2089 by 1764 pixels · retinal fundus photograph: 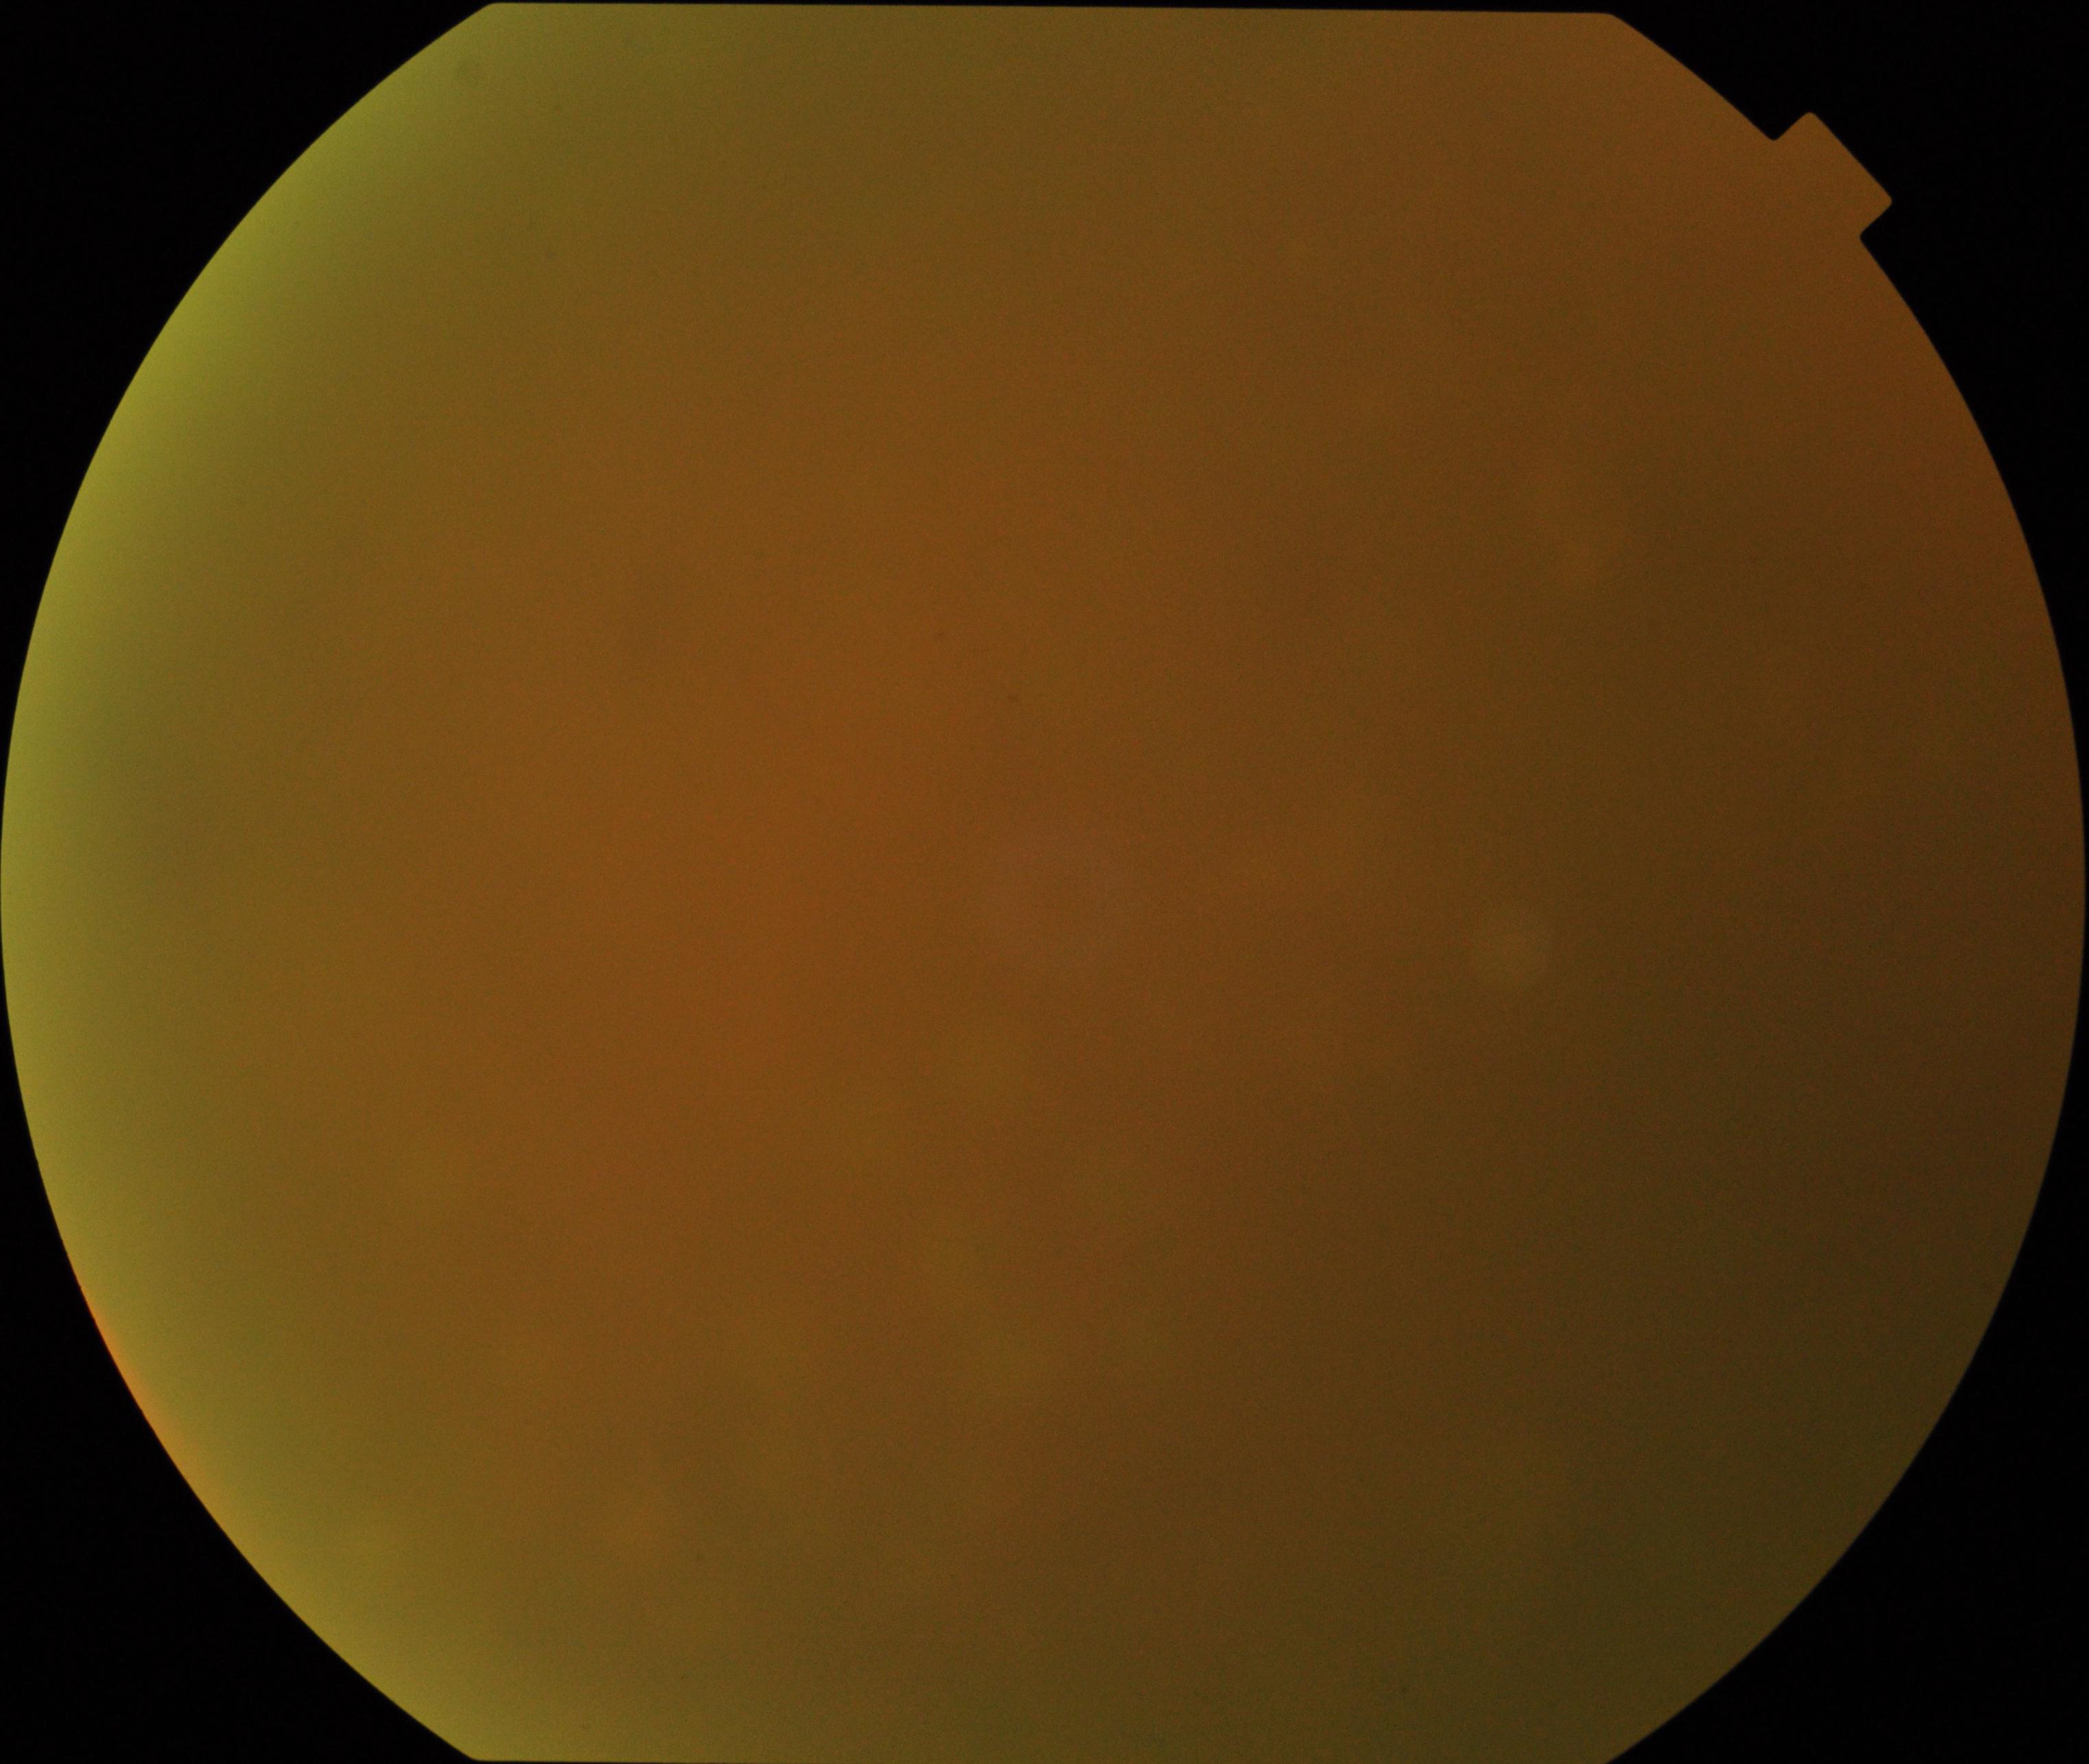 Image is blurred; retinal landmarks are largely obscured. Proliferative diabetic retinopathy not identified in the visible portion.